CFP:
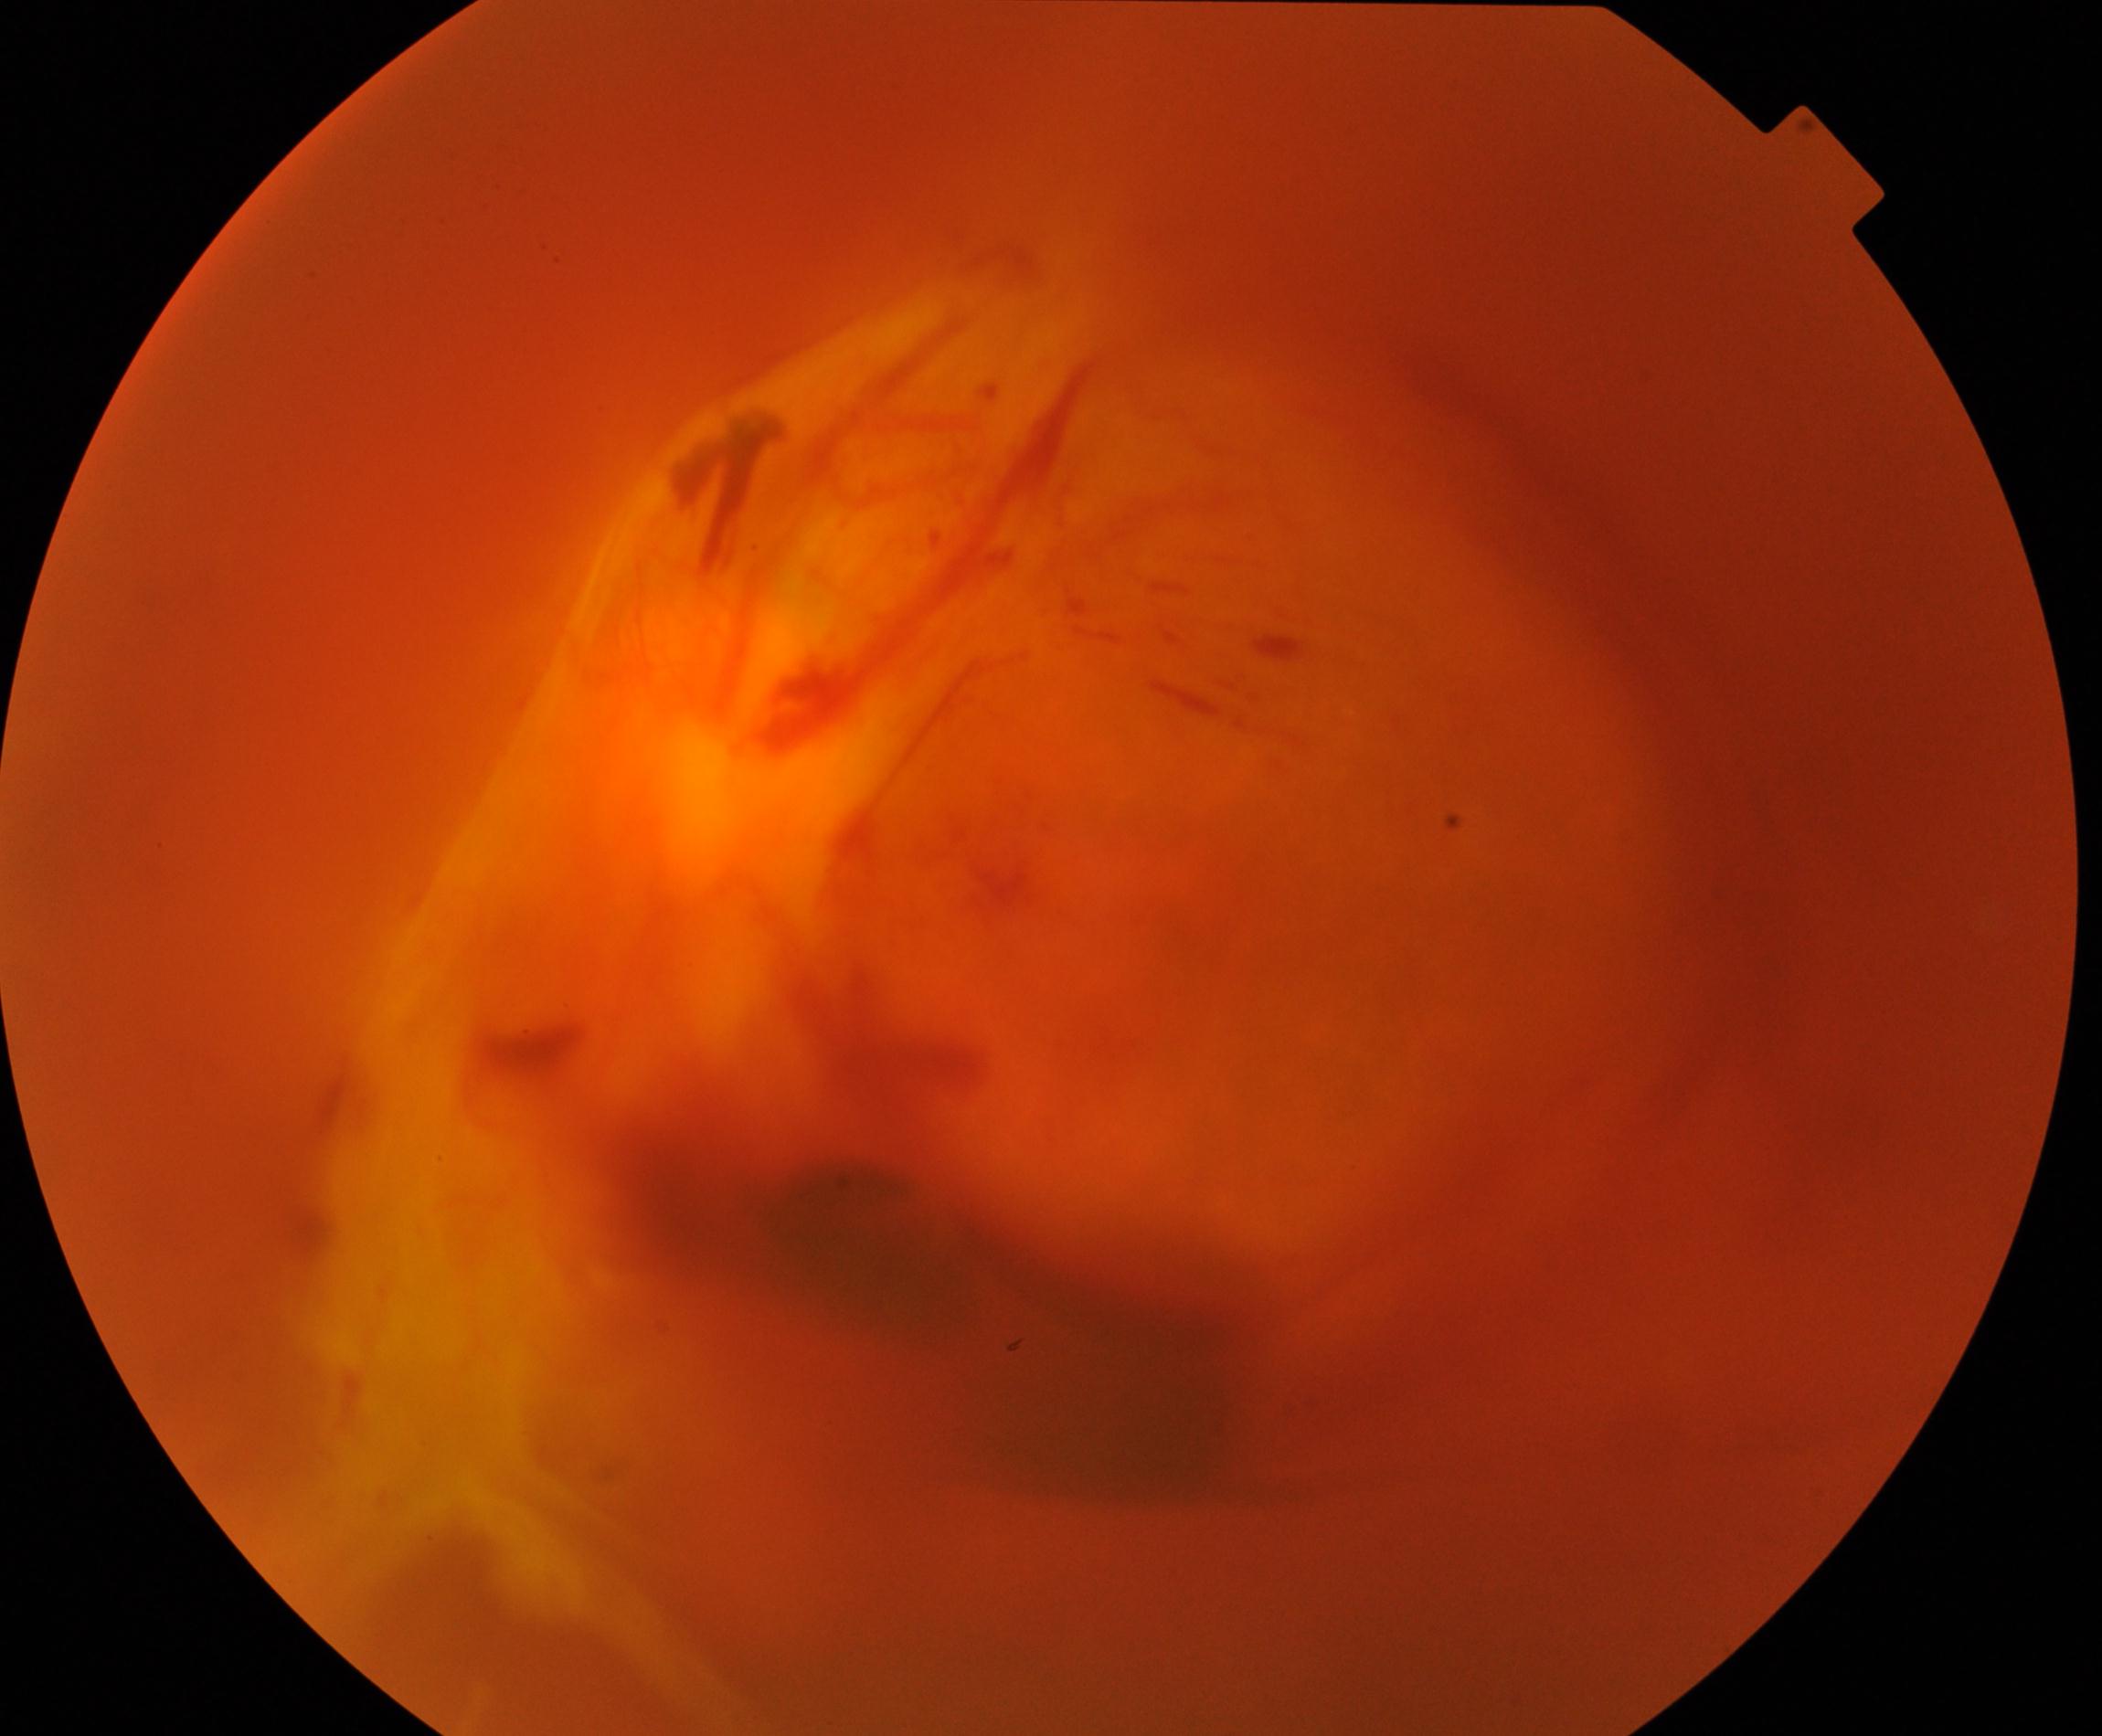 Image quality is poor; more than half the field is obscured. Suspected proliferative diabetic retinopathy.